45° field of view
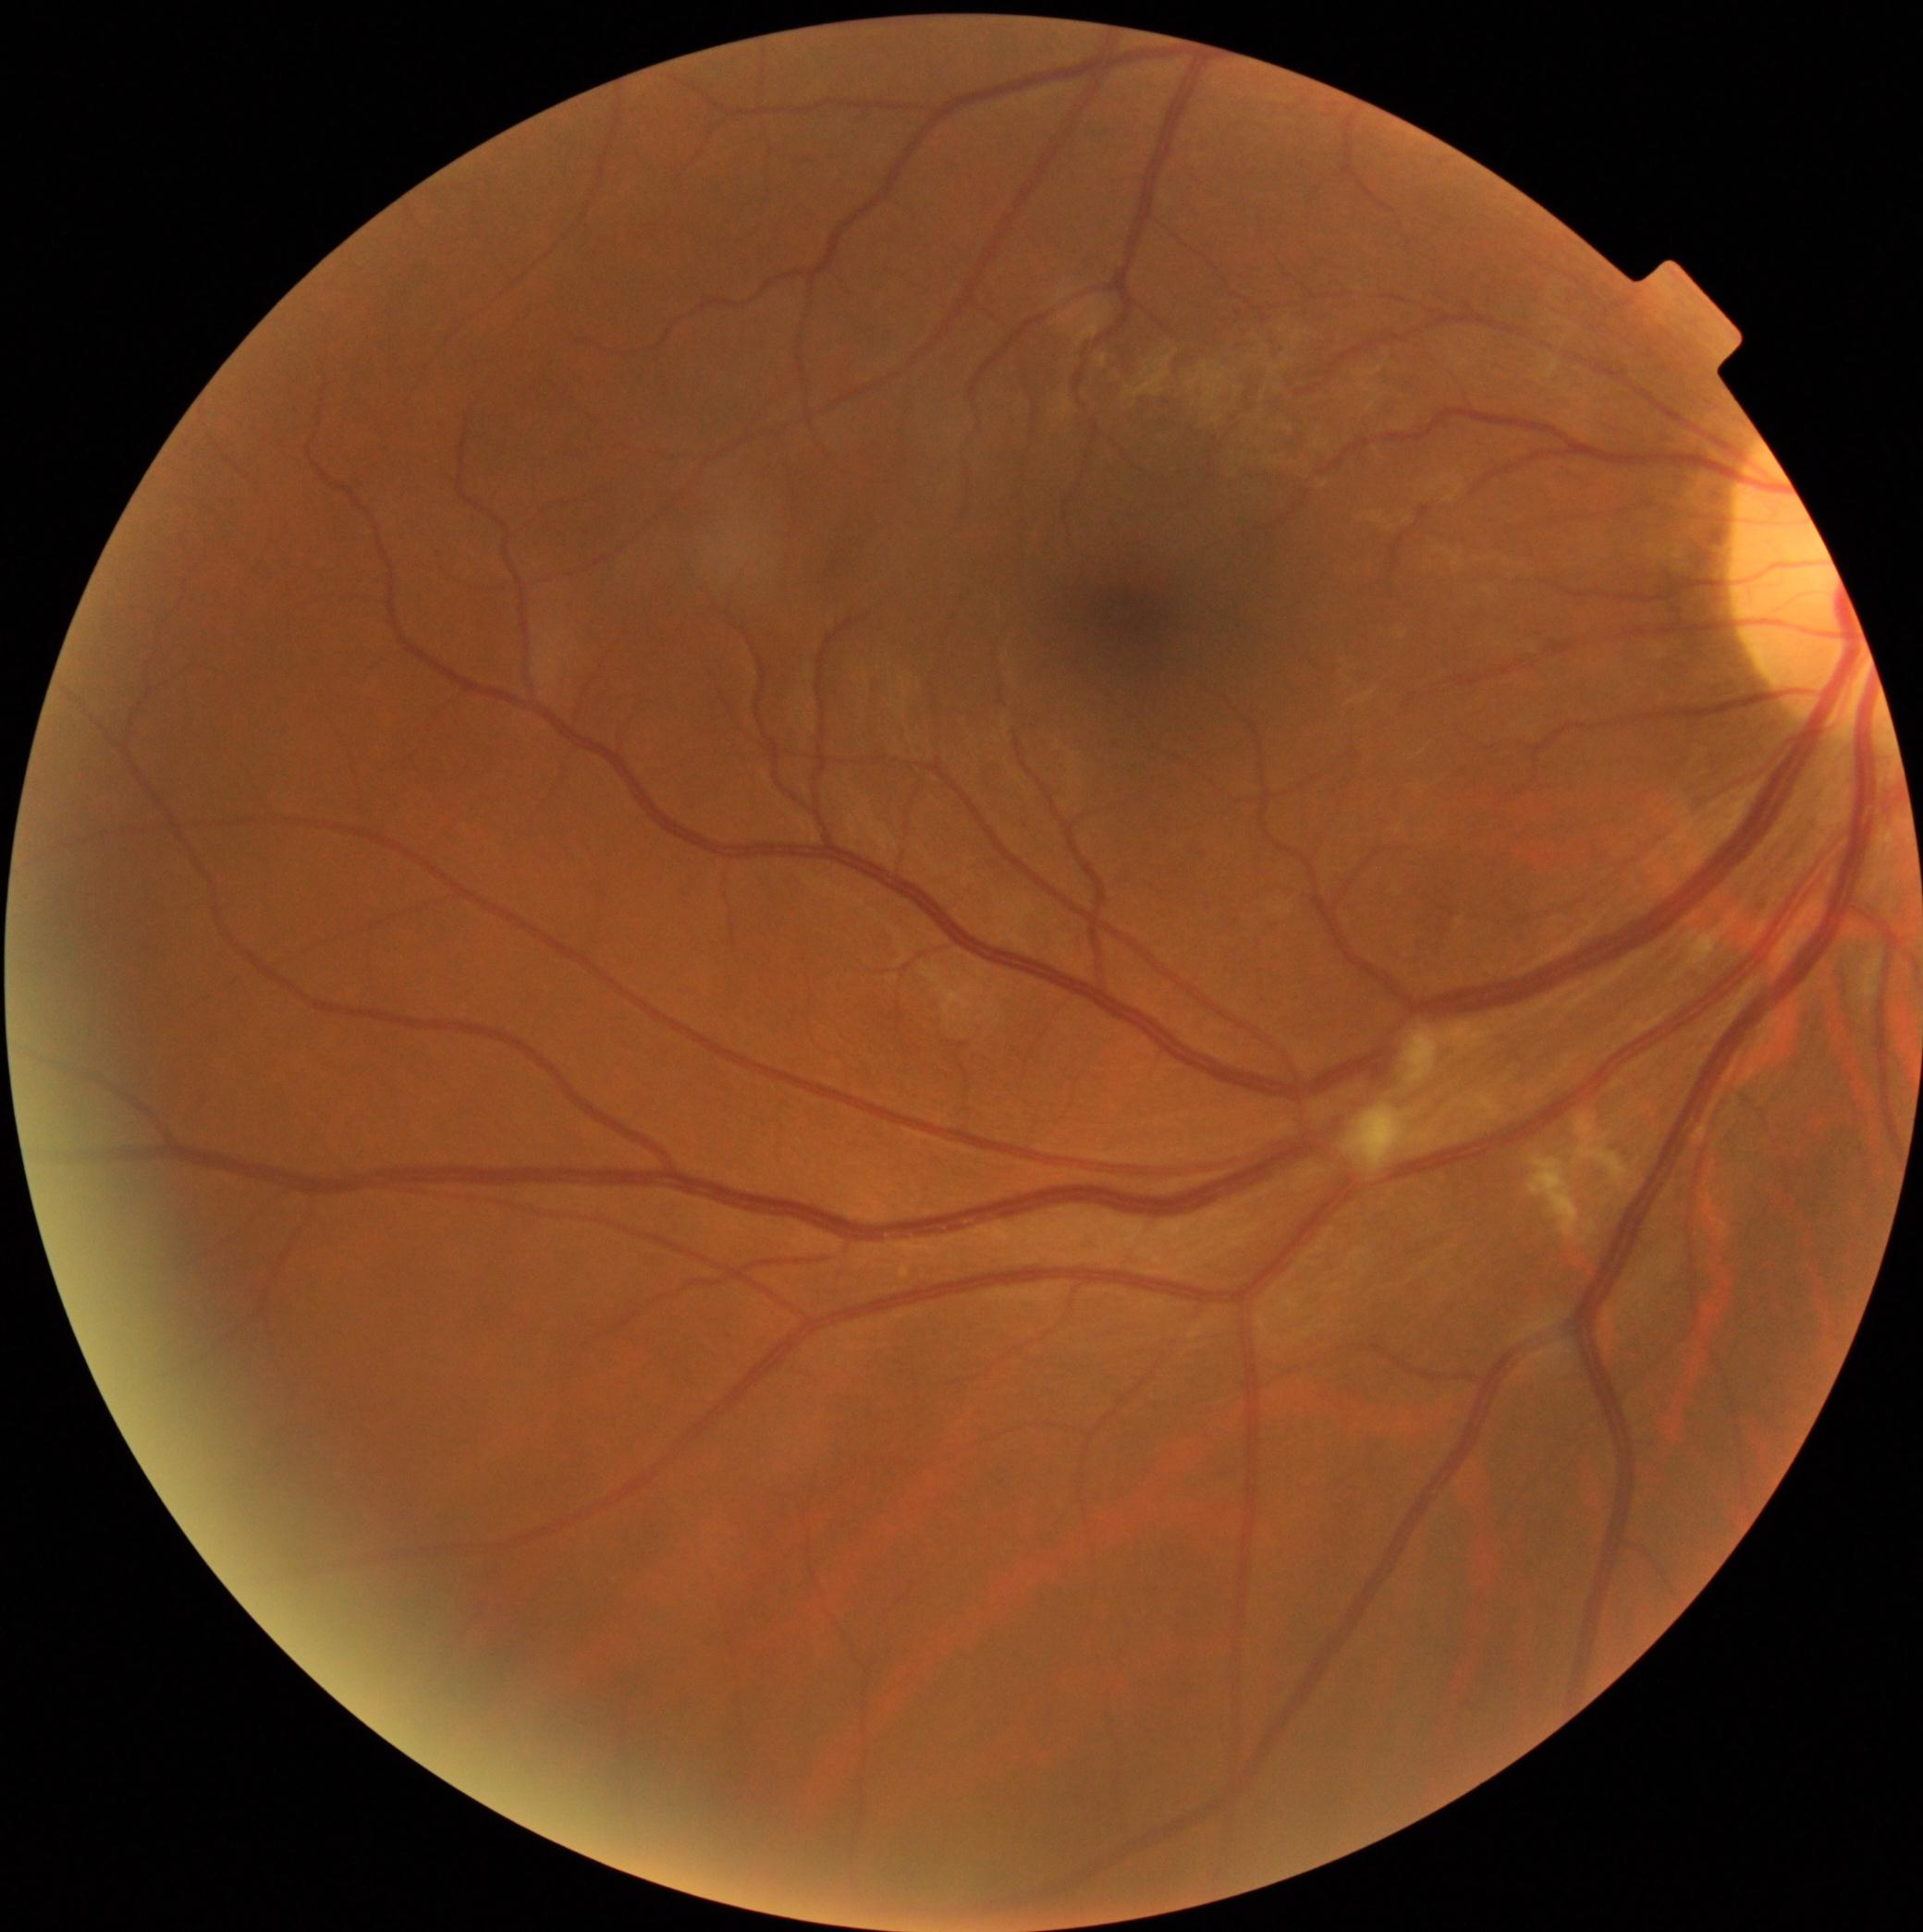
DR severity is 2/4 — more than just microaneurysms but less than severe NPDR.